Wide-field fundus image from infant ROP screening · Clarity RetCam 3, 130° FOV · 640x480 — 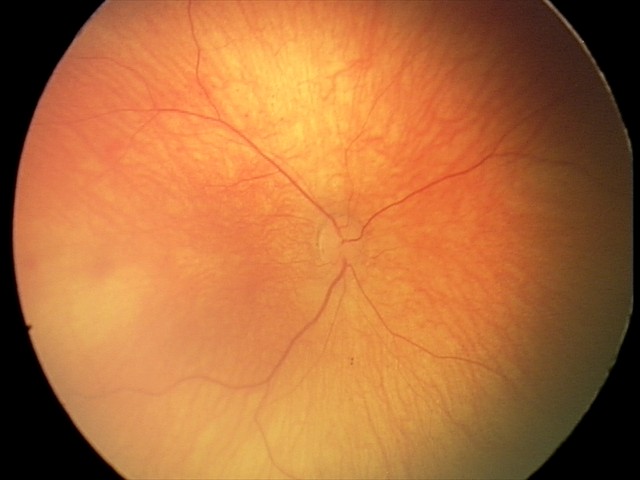 Assessment: no pathology identified.